CFP:
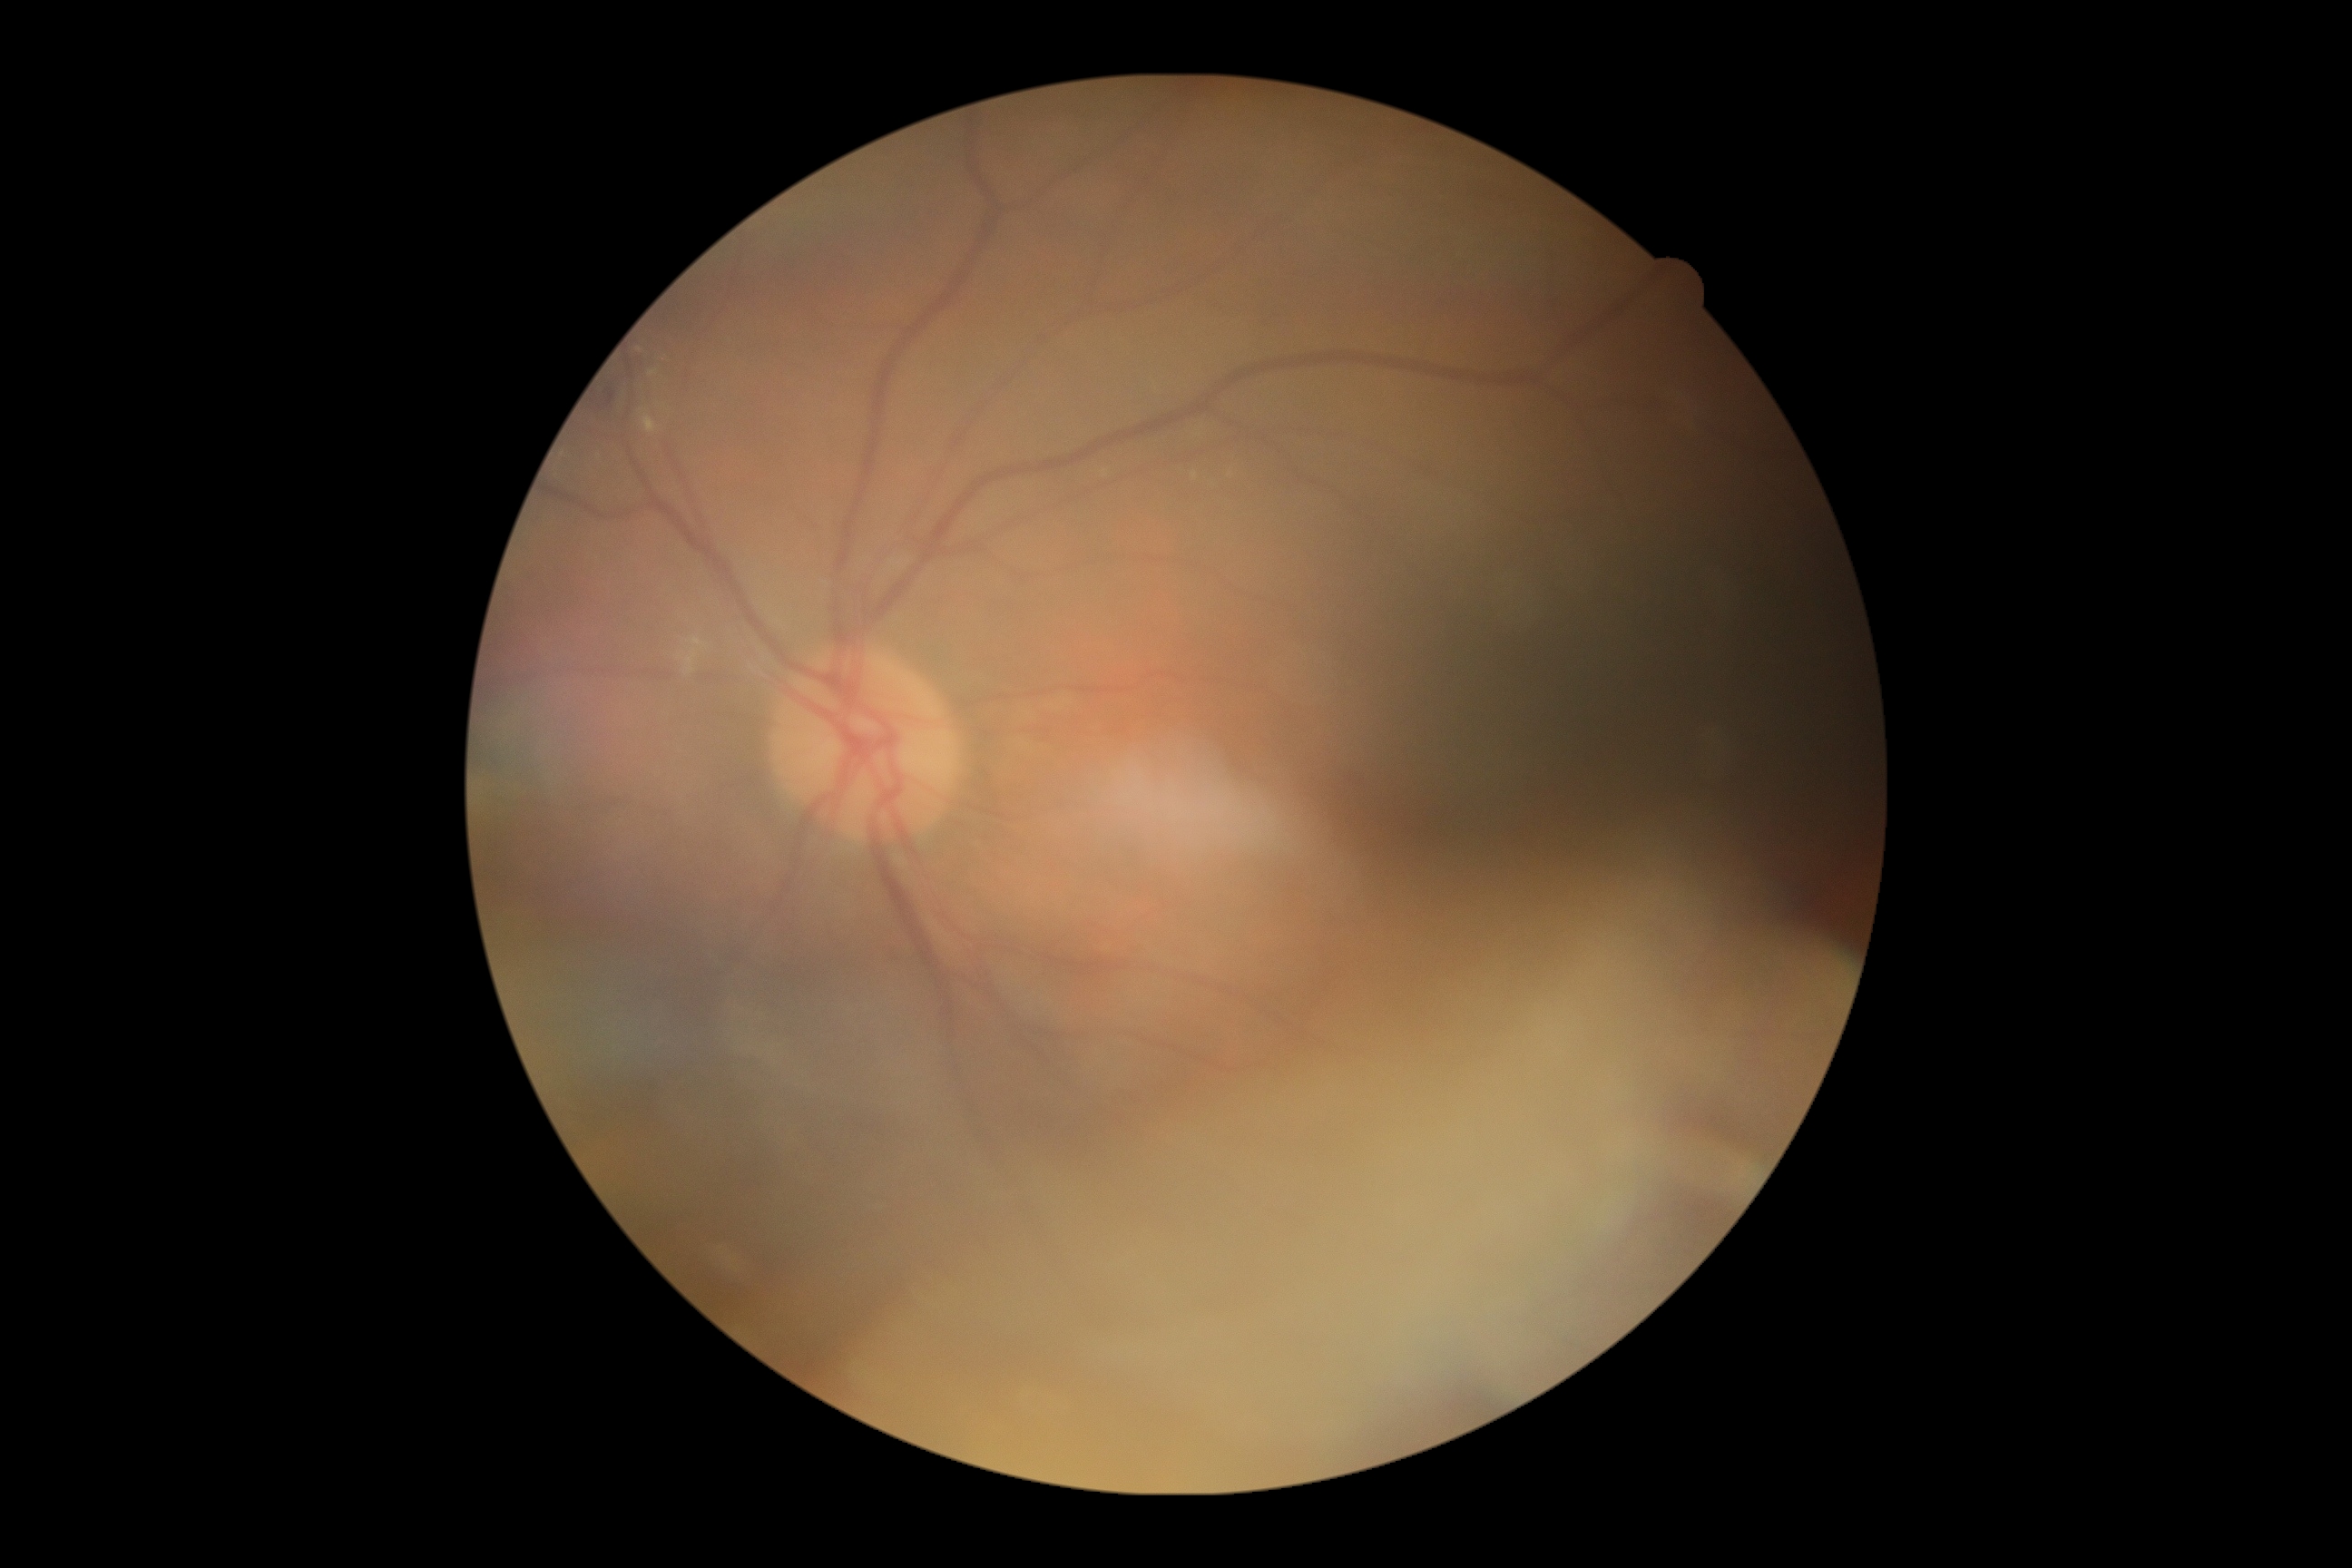

Annotations:
* DR stage: moderate non-proliferative diabetic retinopathy (grade 2)